Color fundus image · captured on a Nidek AFC-330 fundus camera:
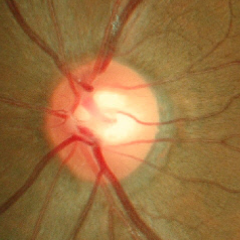
Q: Does this eye have glaucoma?
A: No — no glaucoma.